Age 77. Axial length: 21.7 mm. IOP by Perkins applanation tonometry: 16 mmHg
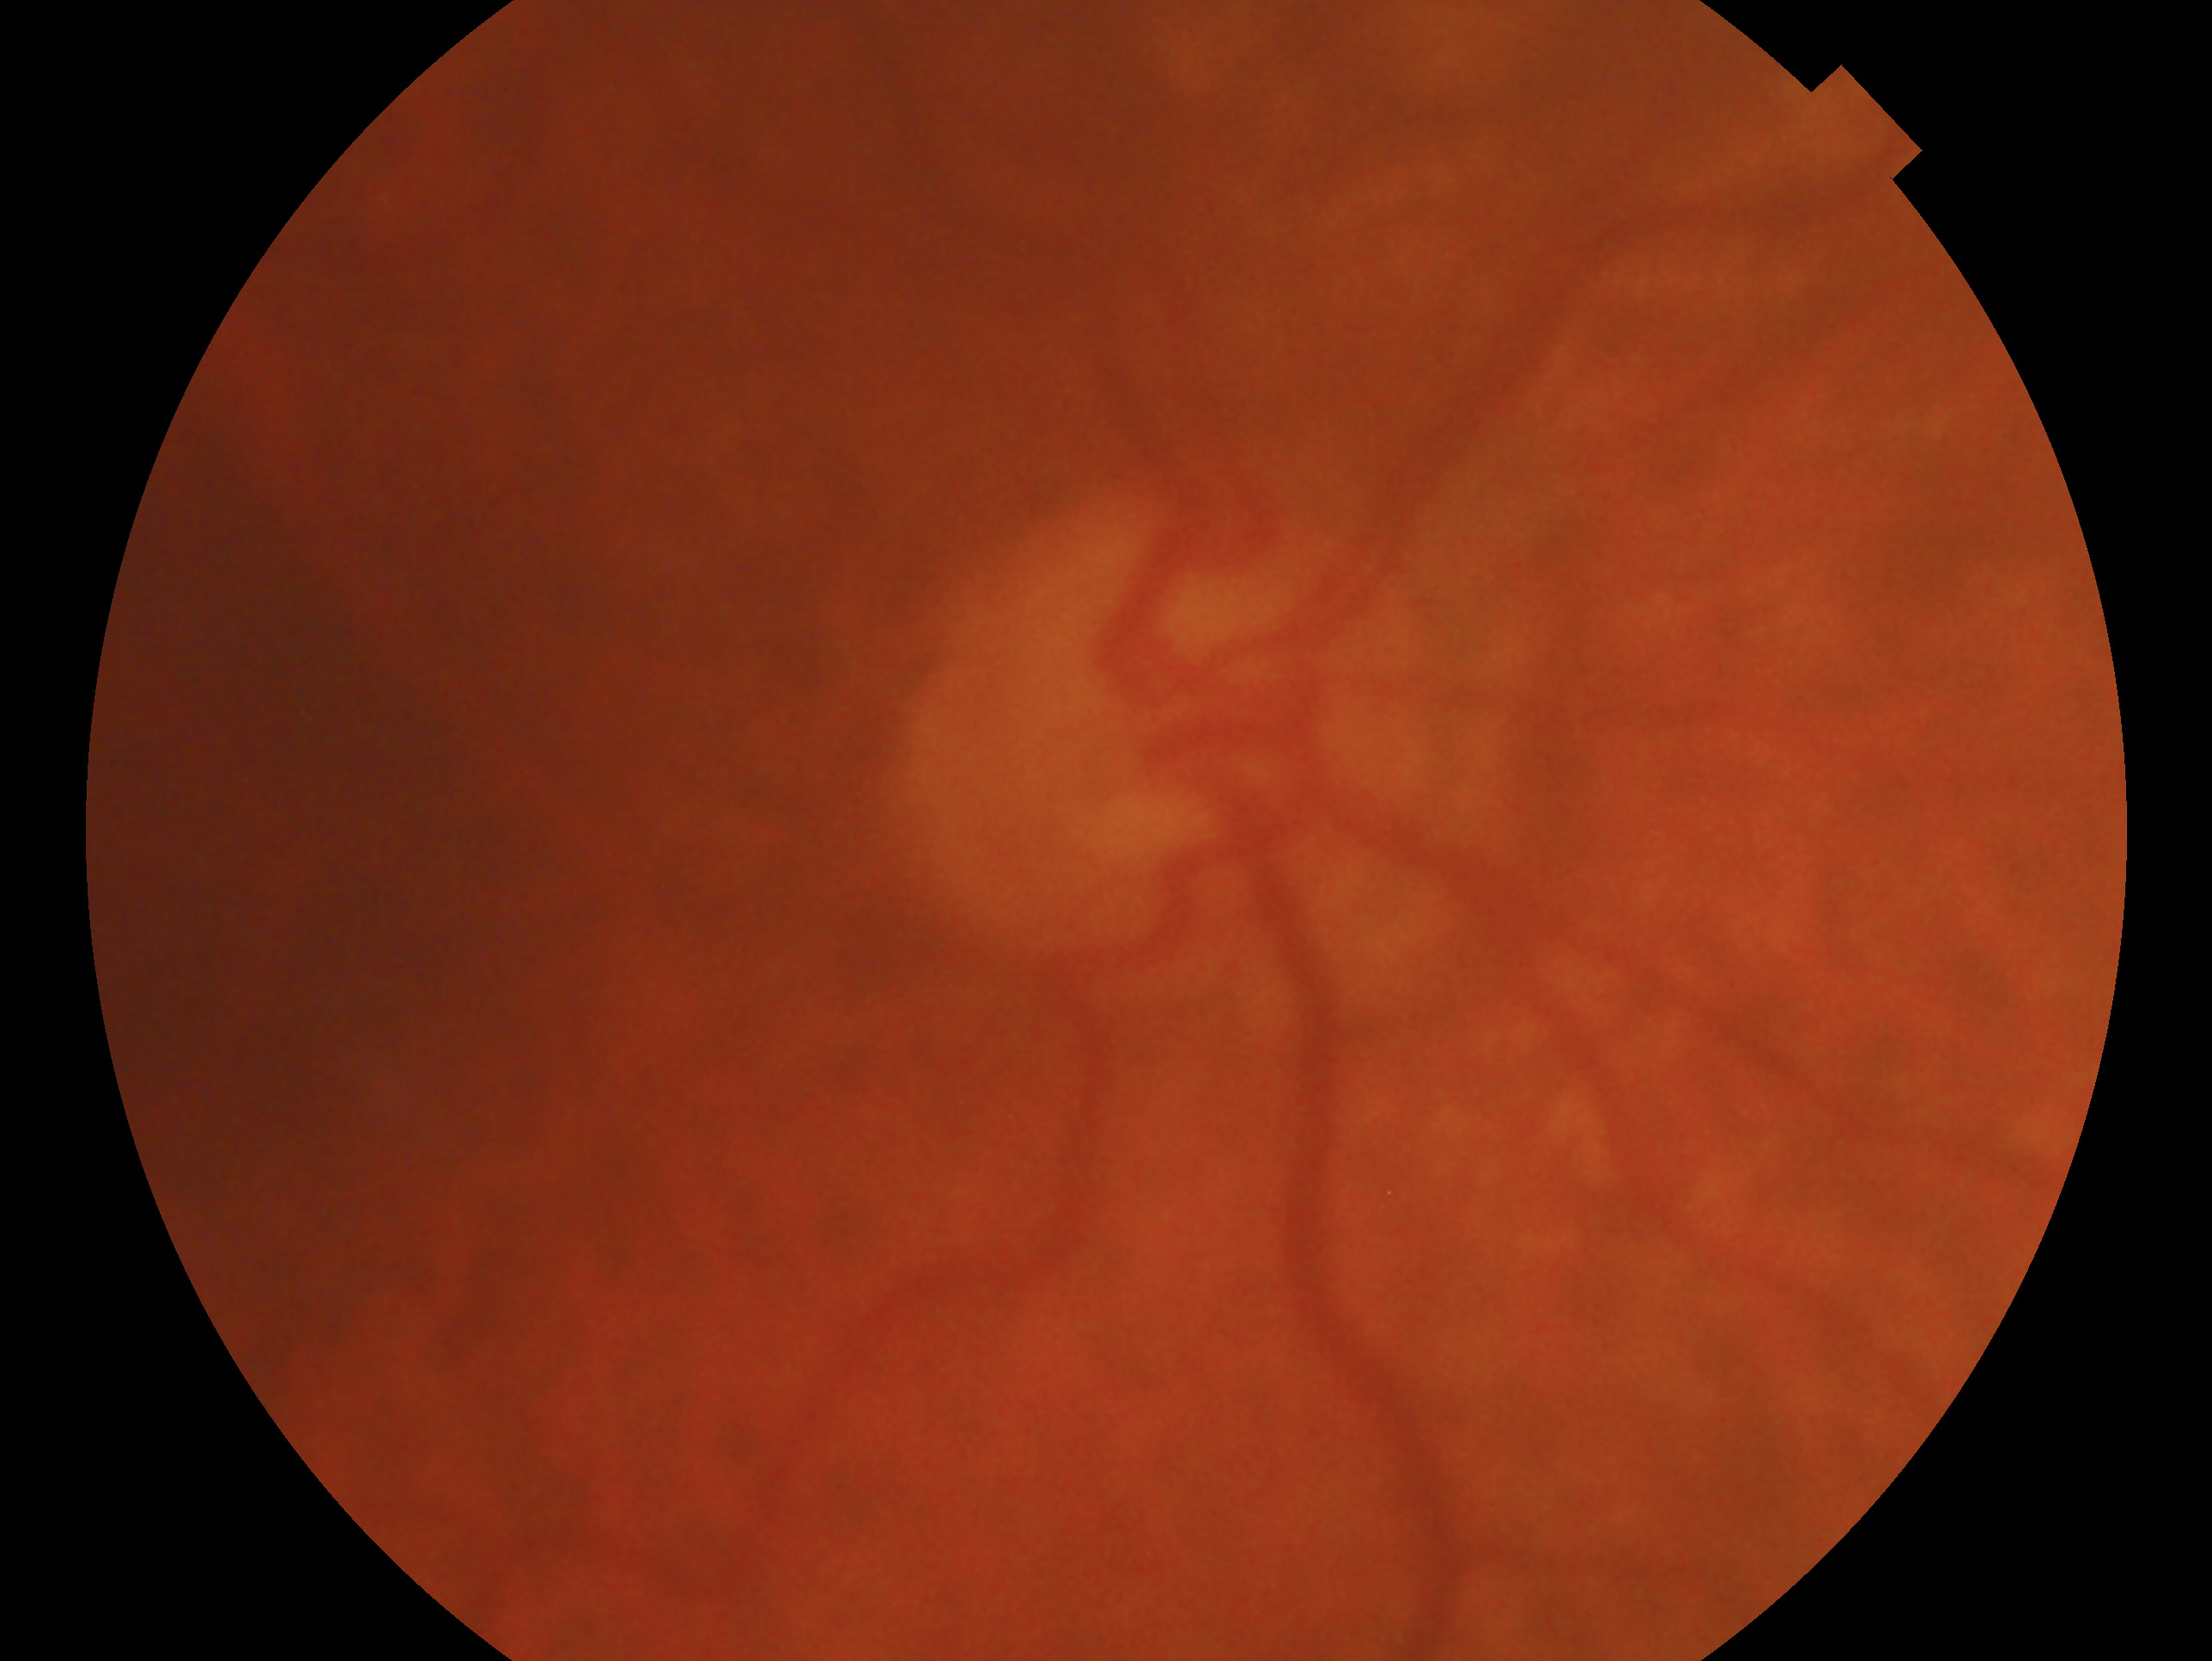 Assessment: glaucomatous optic neuropathy. The image shows the OD.